Color fundus photograph centered on the optic disc — 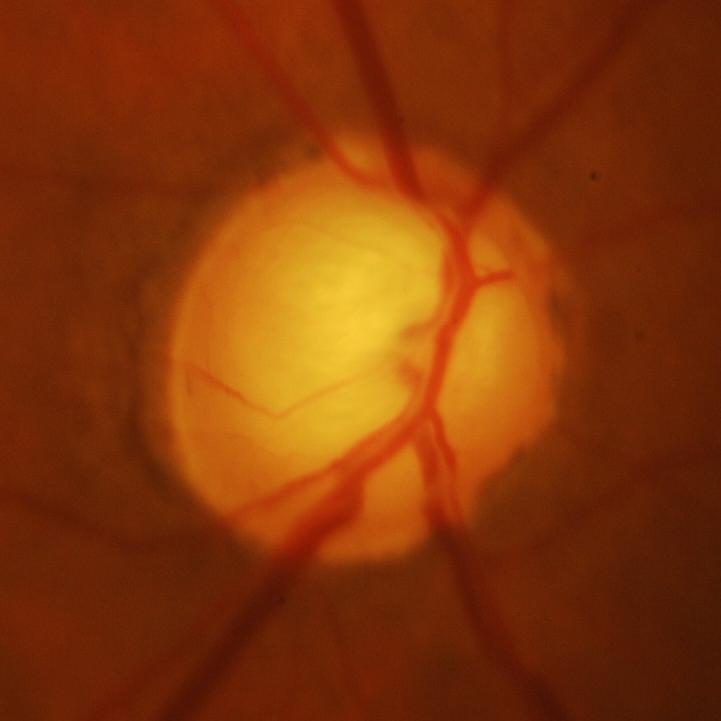

Optic disc appearance consistent with evidence of glaucoma.